848x848px; acquired with a NIDEK AFC-230 — 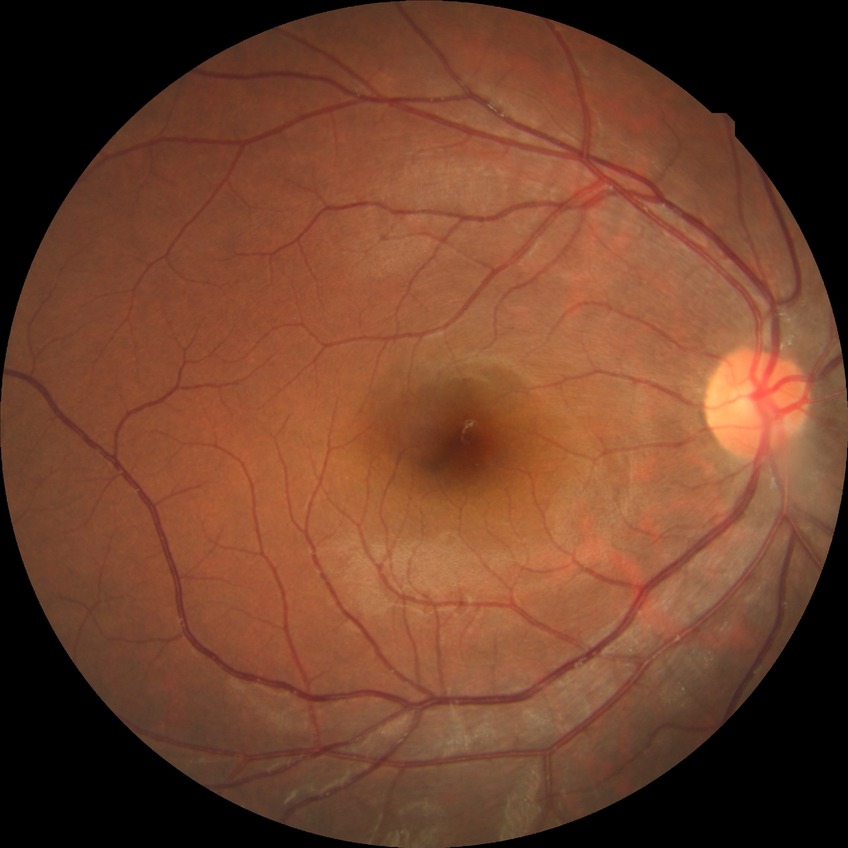
diabetic retinopathy (DR)=no diabetic retinopathy (NDR).